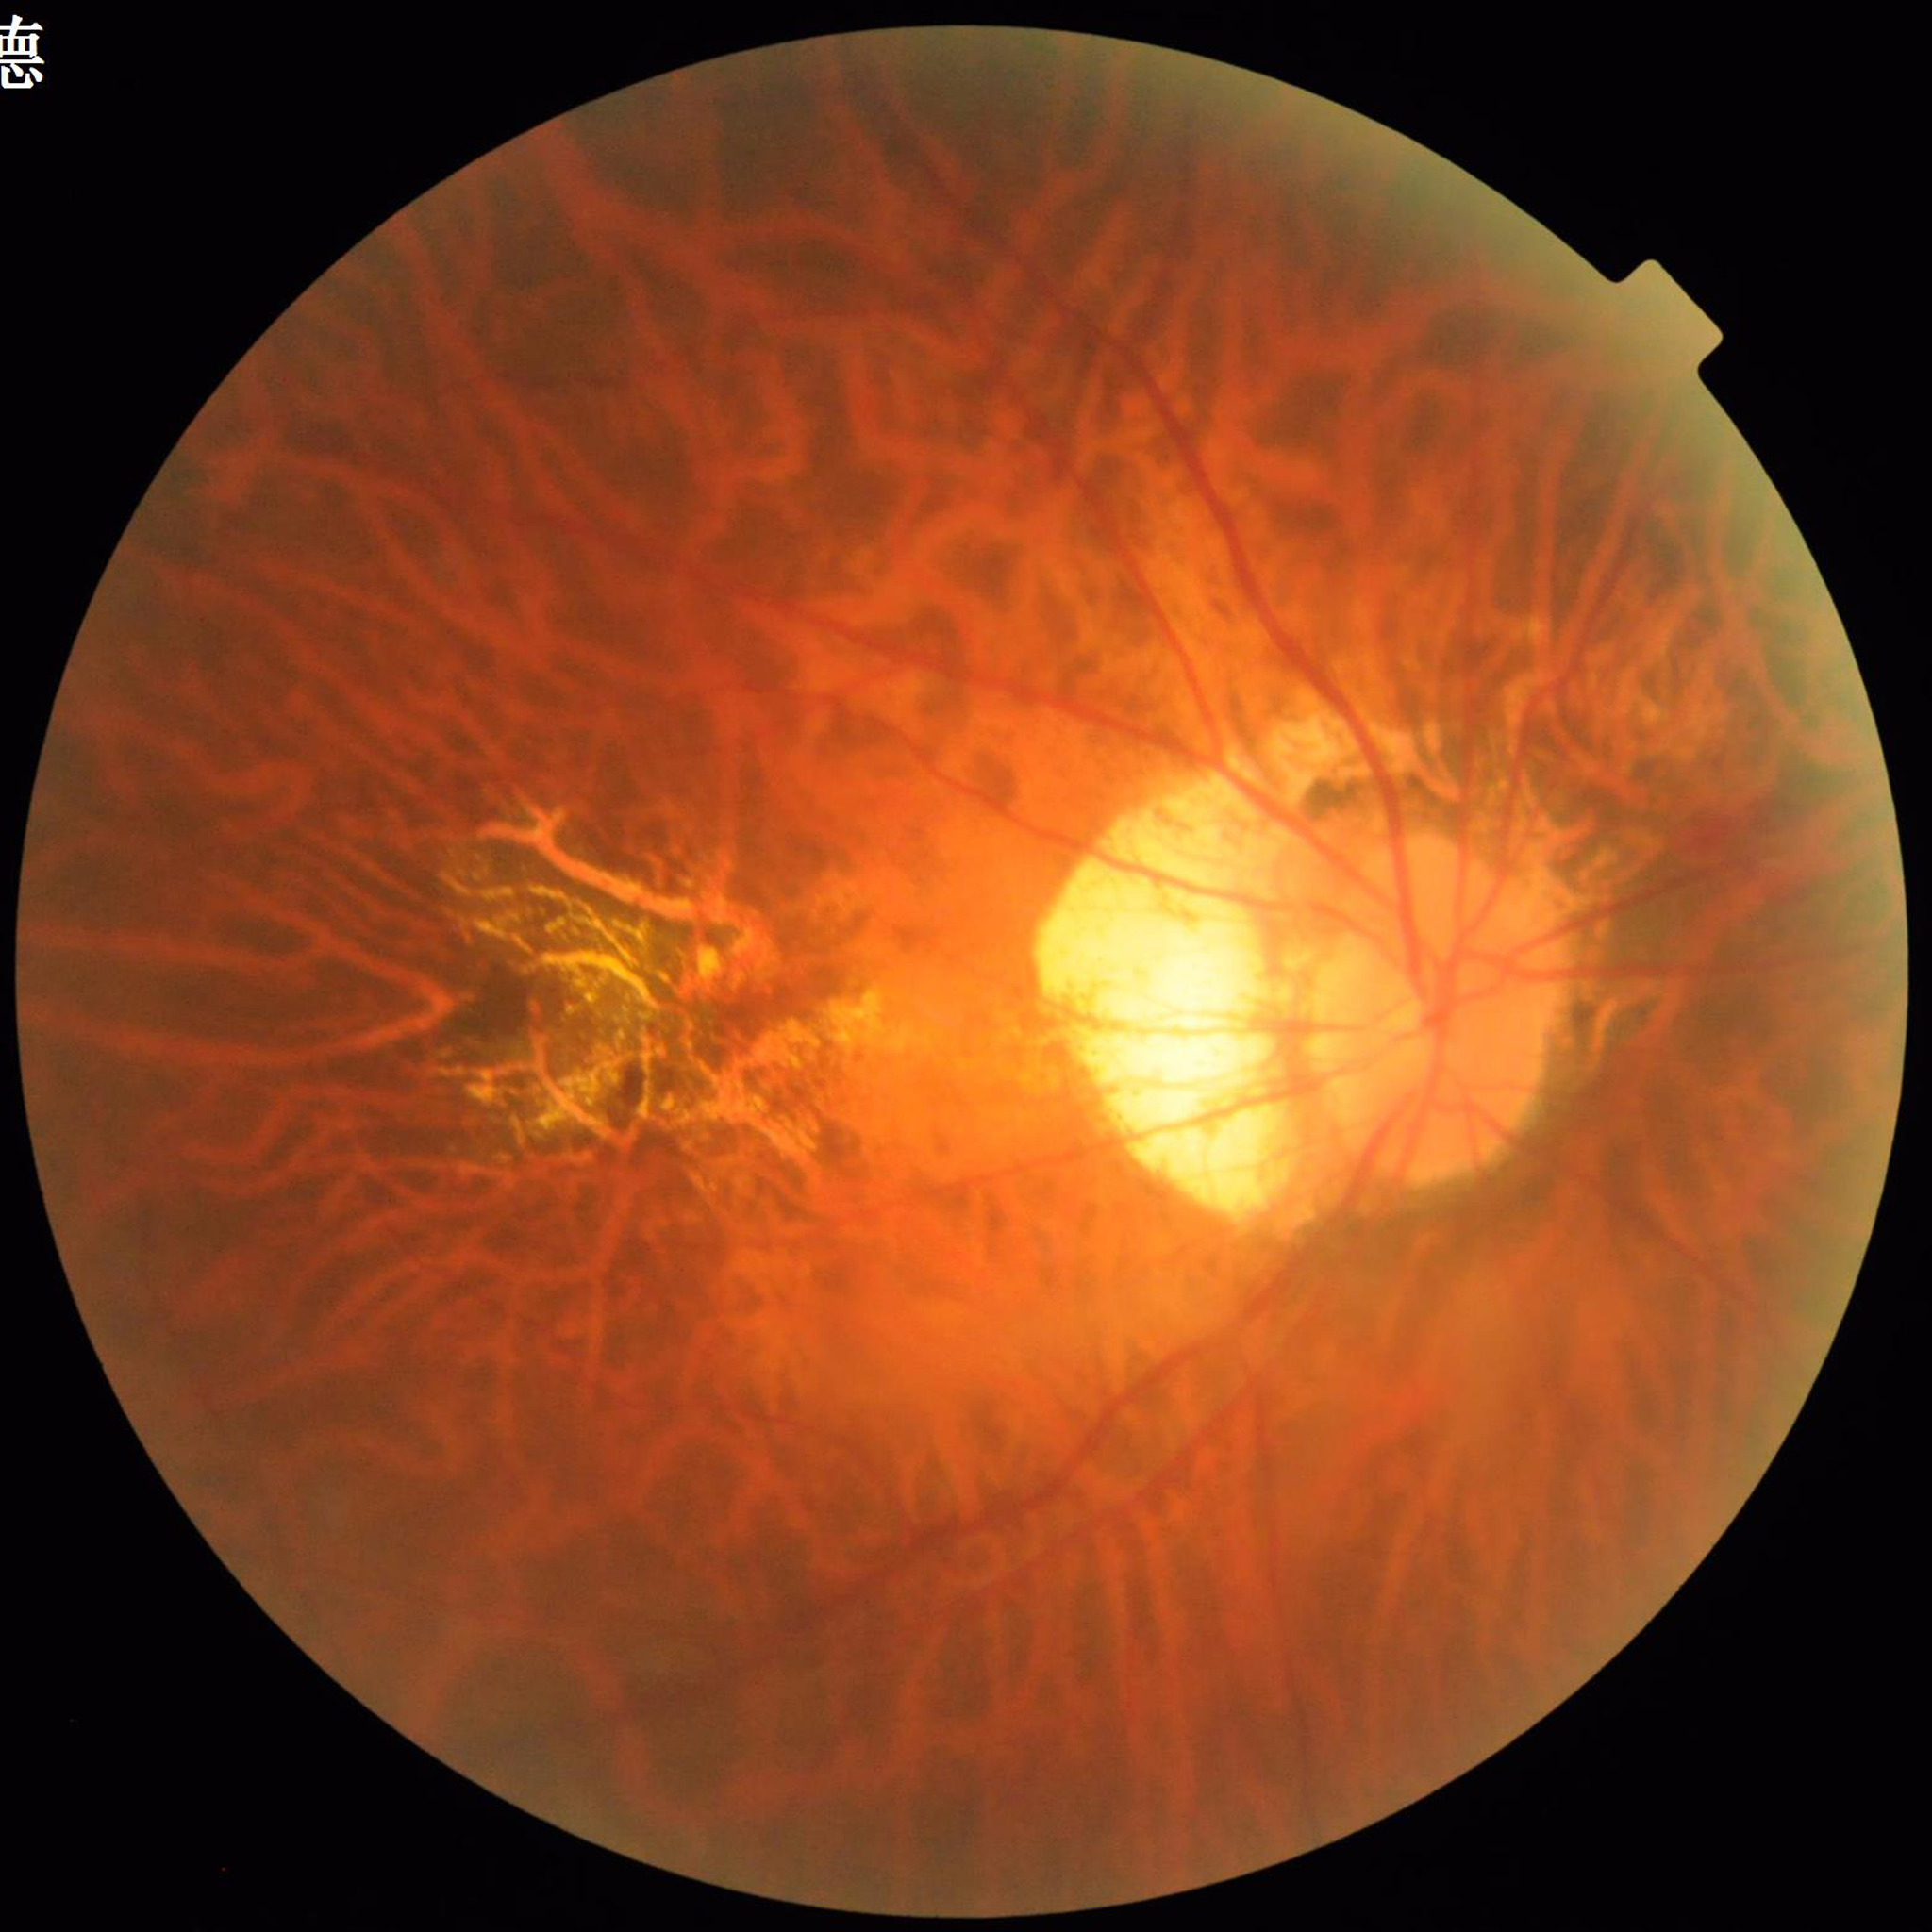
{
  "image_quality": "contrast adequate, illumination and color satisfactory, no blur",
  "diagnosis": "age-related macular degeneration"
}